No pharmacologic dilation · graded on the modified Davis scale · acquired with a NIDEK AFC-230
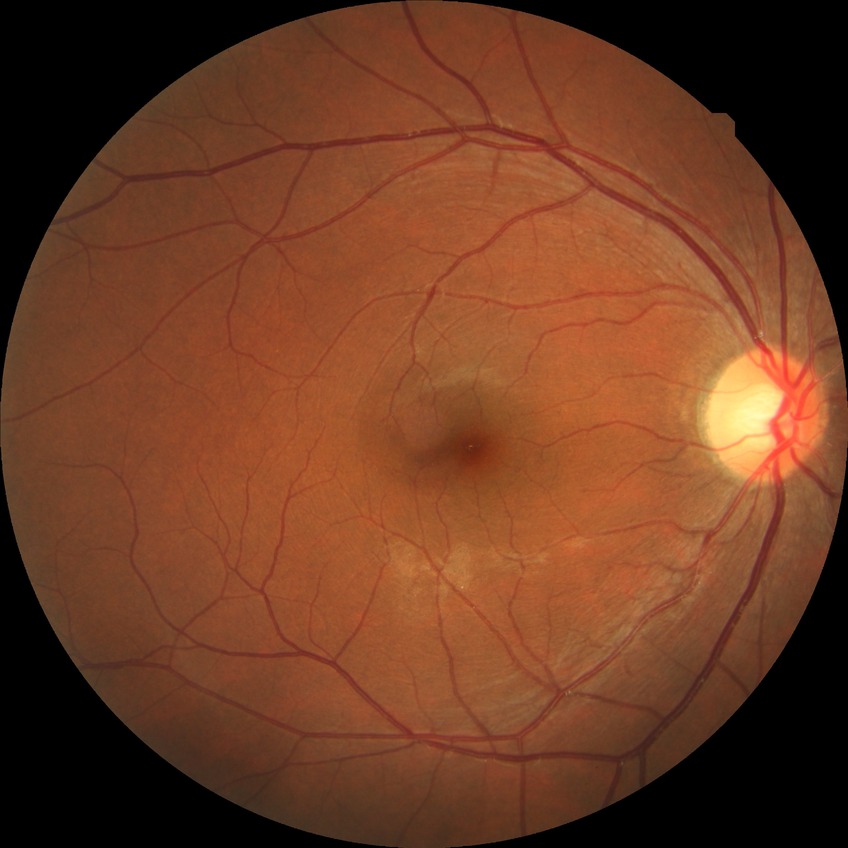
diabetic retinopathy (DR): NDR (no diabetic retinopathy).